Camera: Remidio smartphone fundus camera · image size 1659x2212:
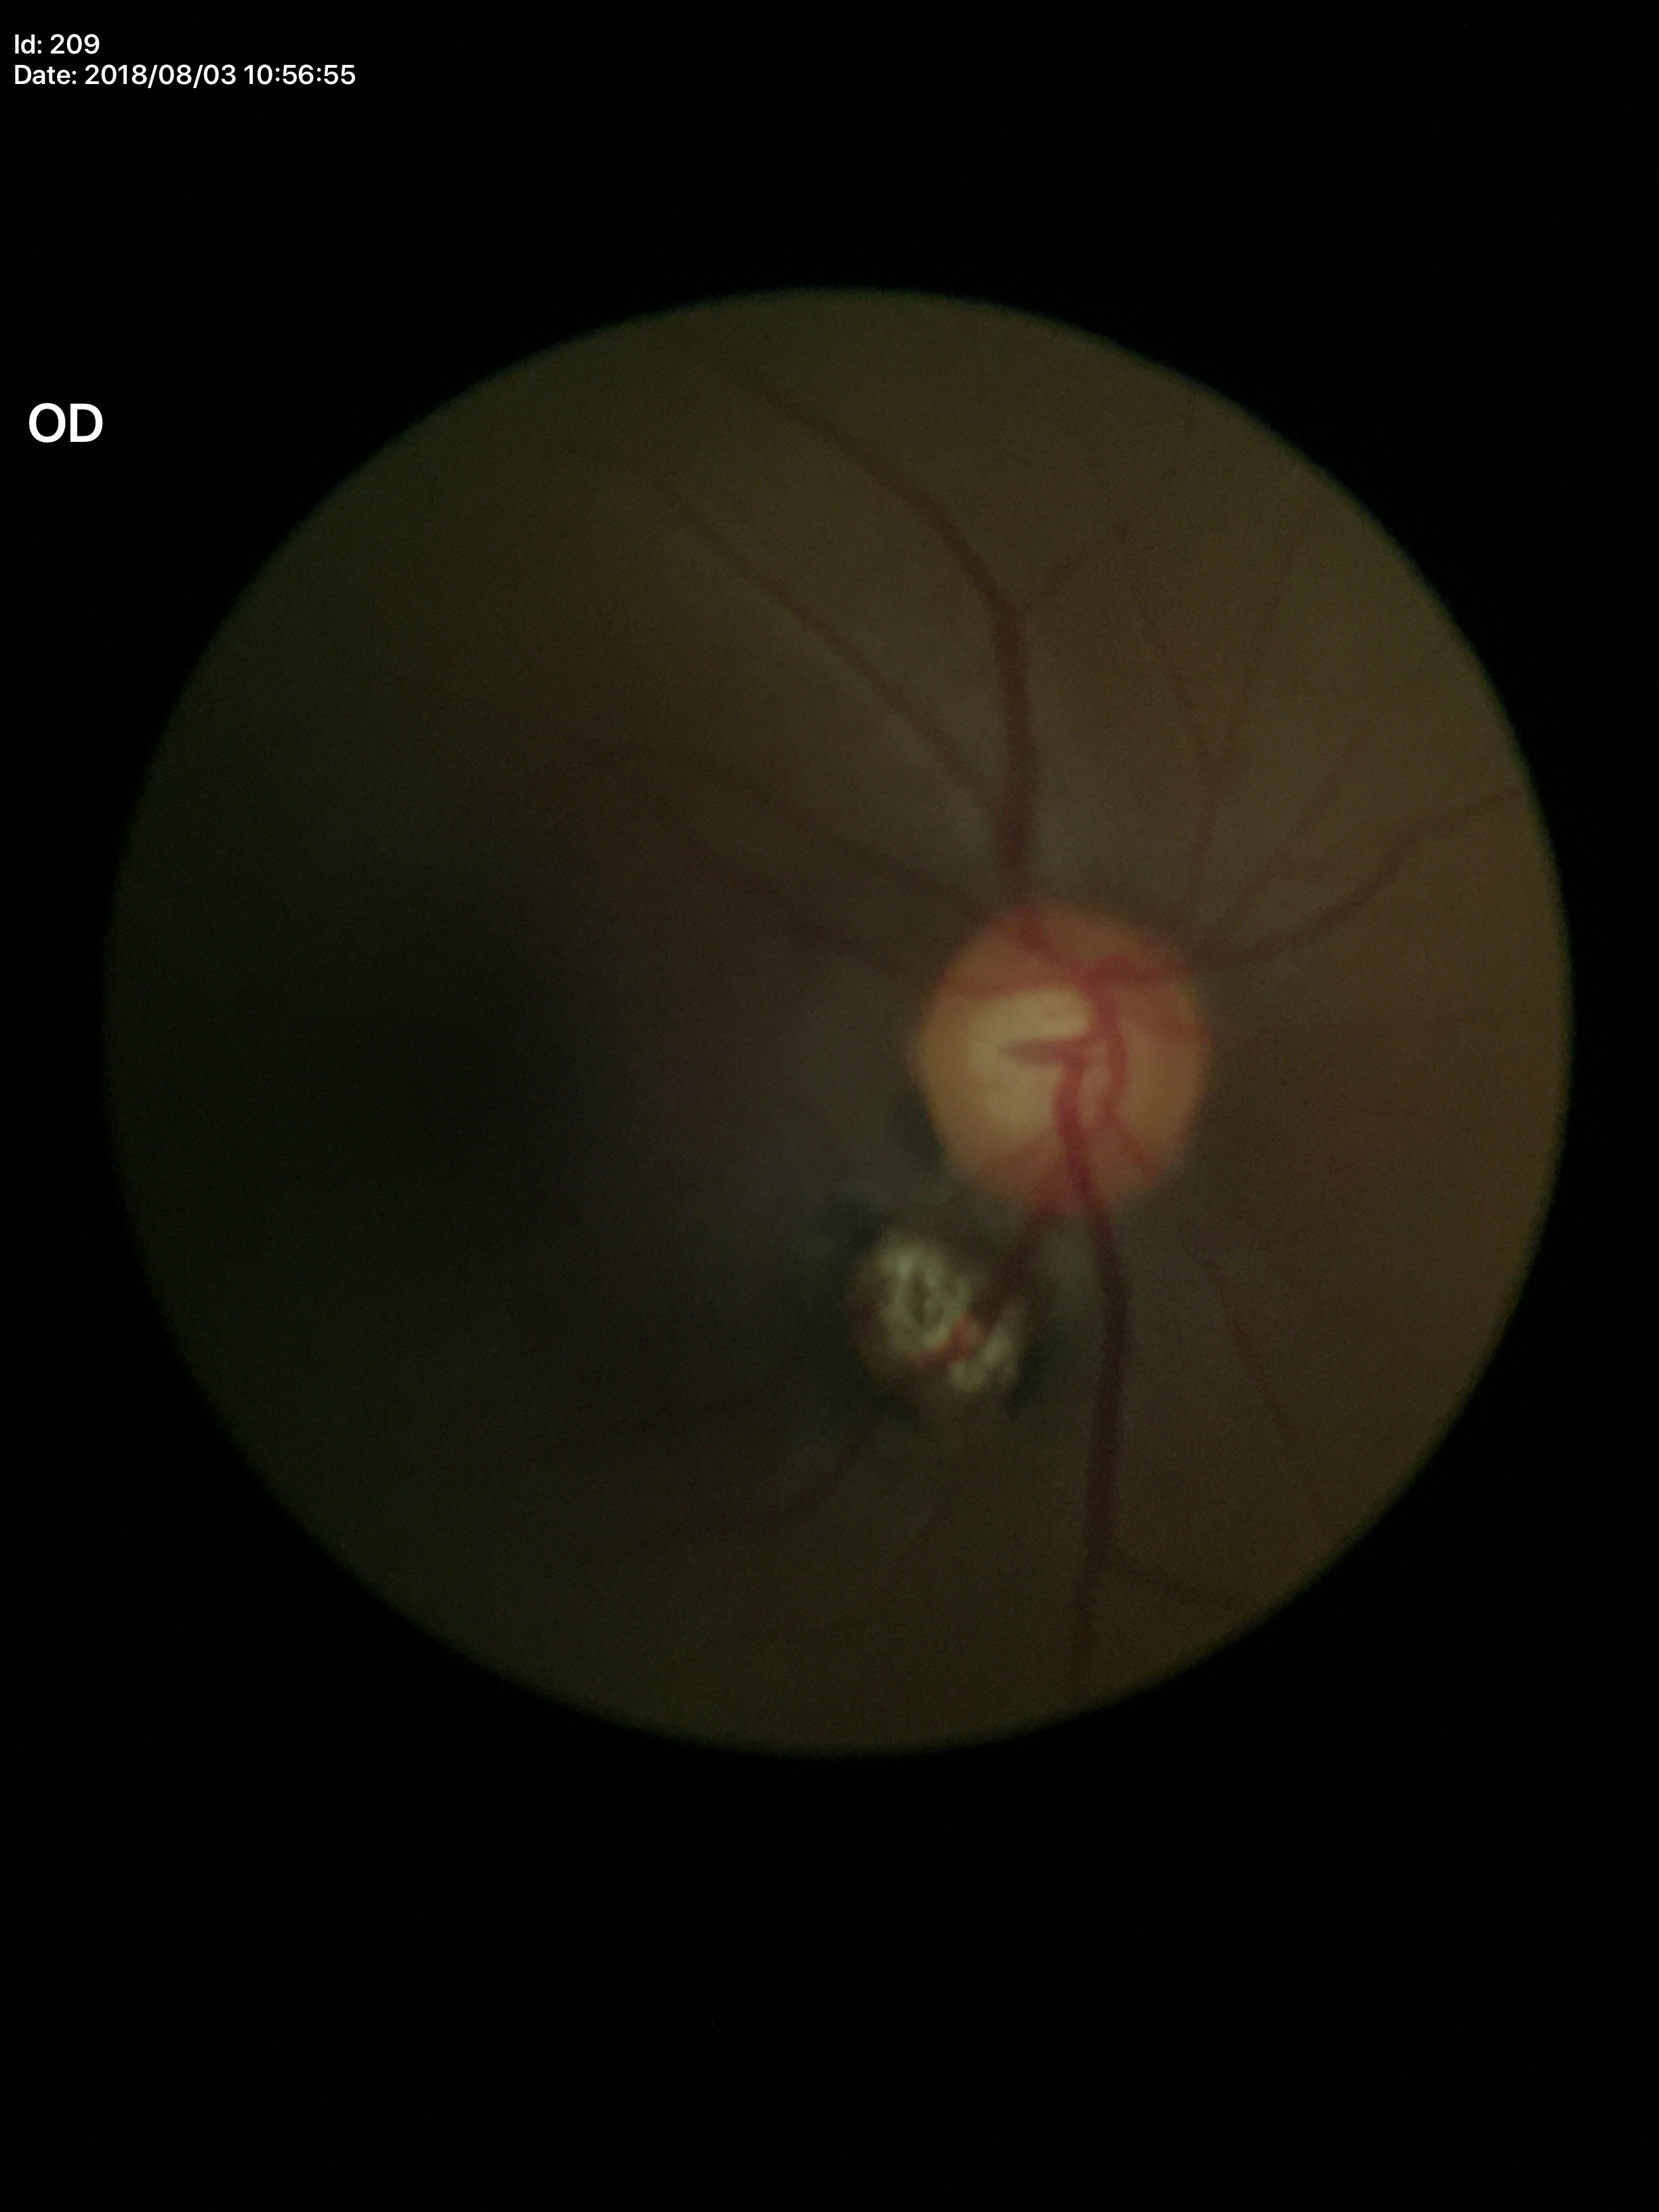 hcdr: 0.58
vcdr: 0.57
glaucoma_decision: not suspect